Color fundus image; 45-degree field of view — 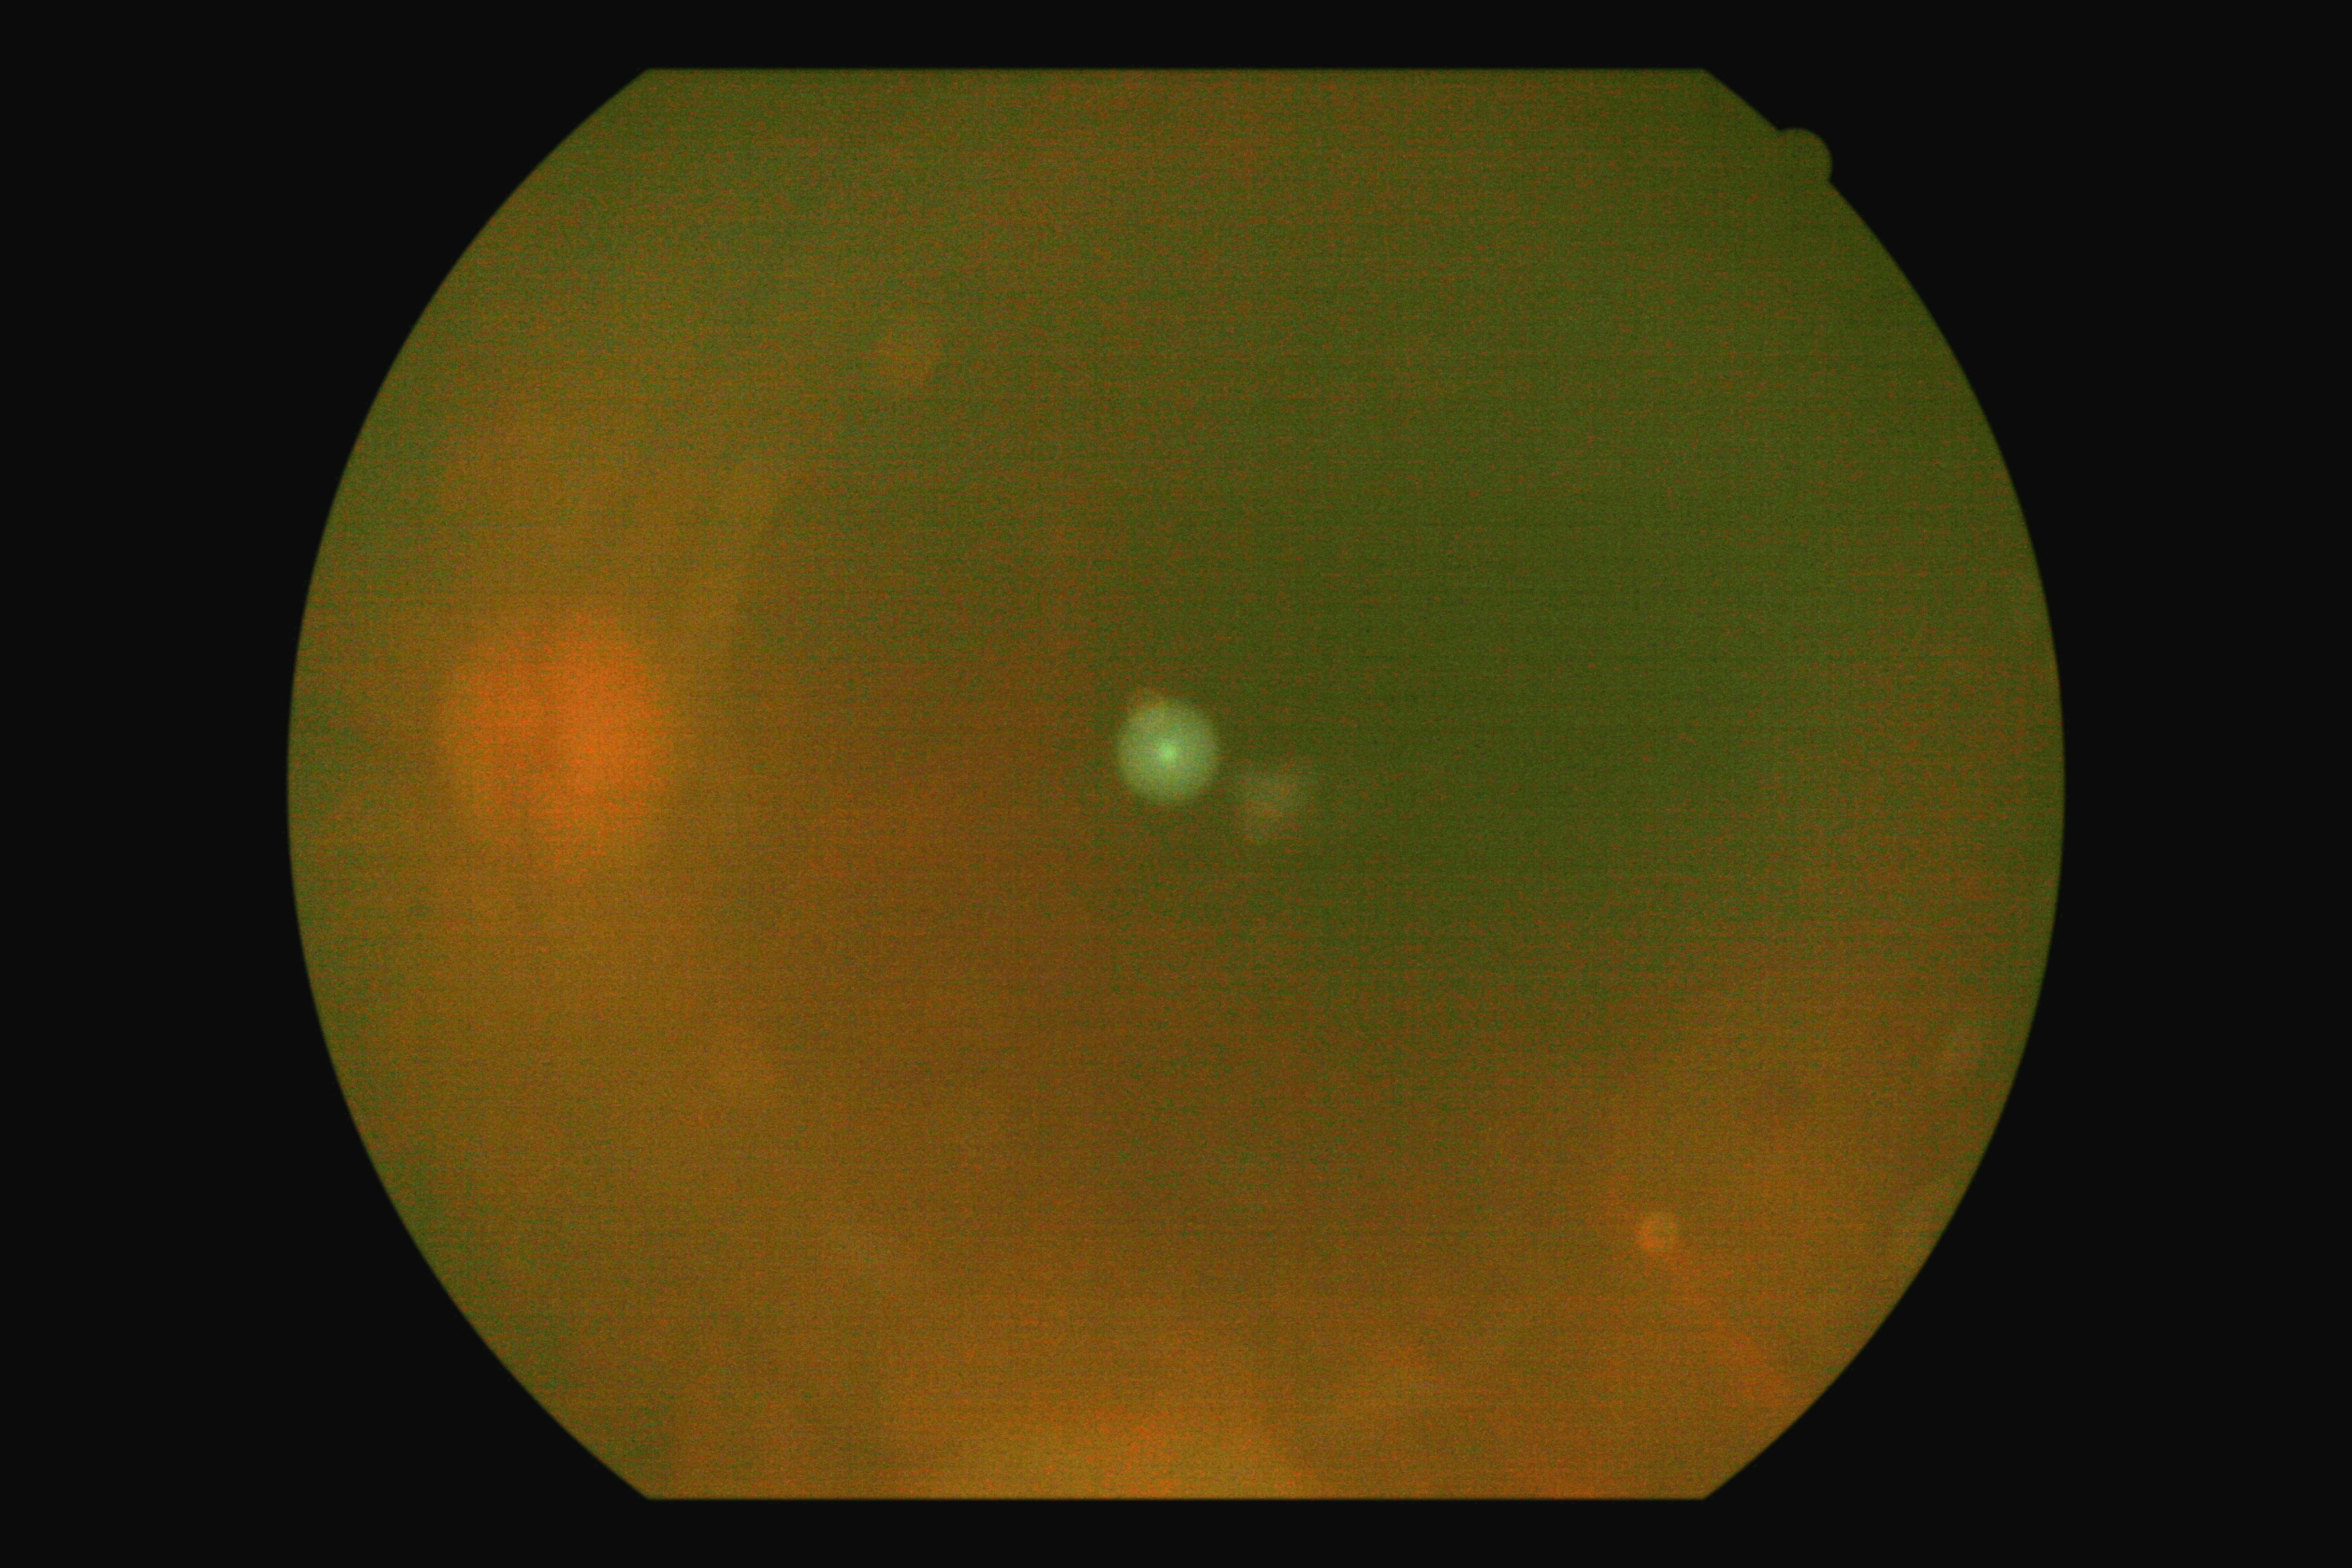

Image quality is insufficient for diabetic retinopathy assessment.
DR is ungradable.